Color fundus image, captured after pupil dilation:
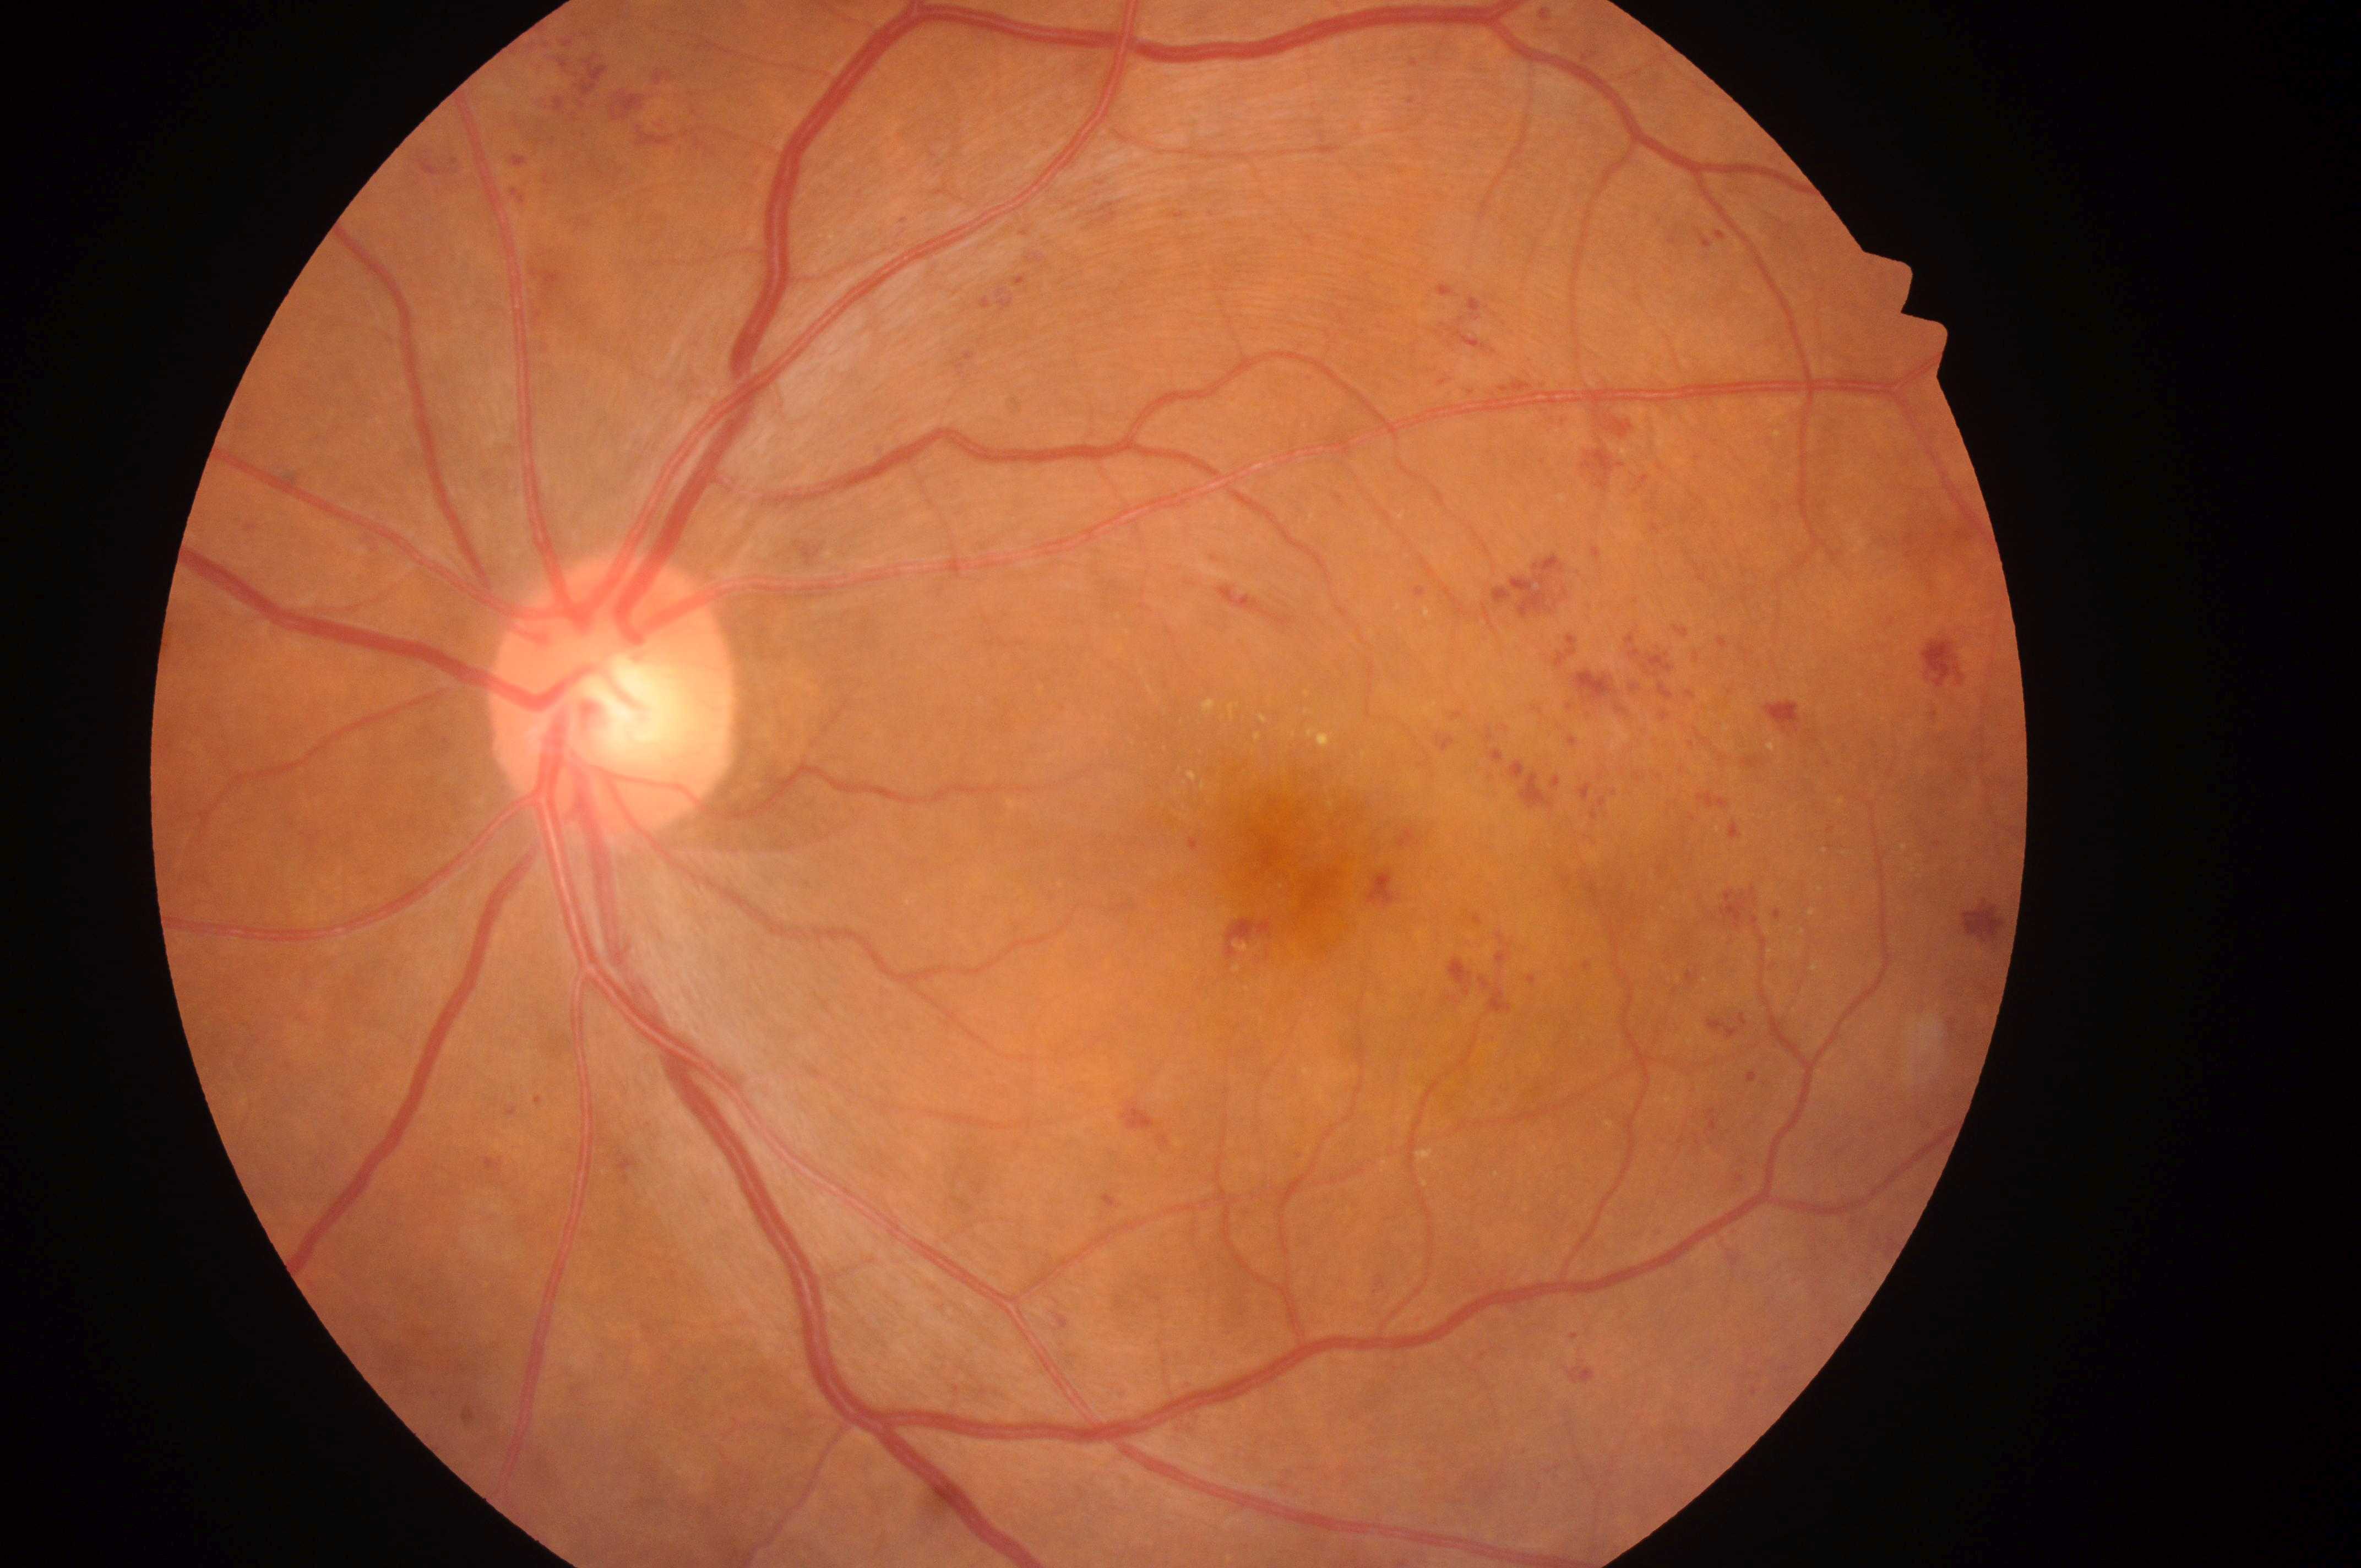
The image shows the left eye.
ONH located at (606,703).
DME: high risk (grade 2).
DR is severe NPDR (grade 3).
Fovea located at (1289,866).